Handheld portable fundus camera image; FOV: 60 degrees:
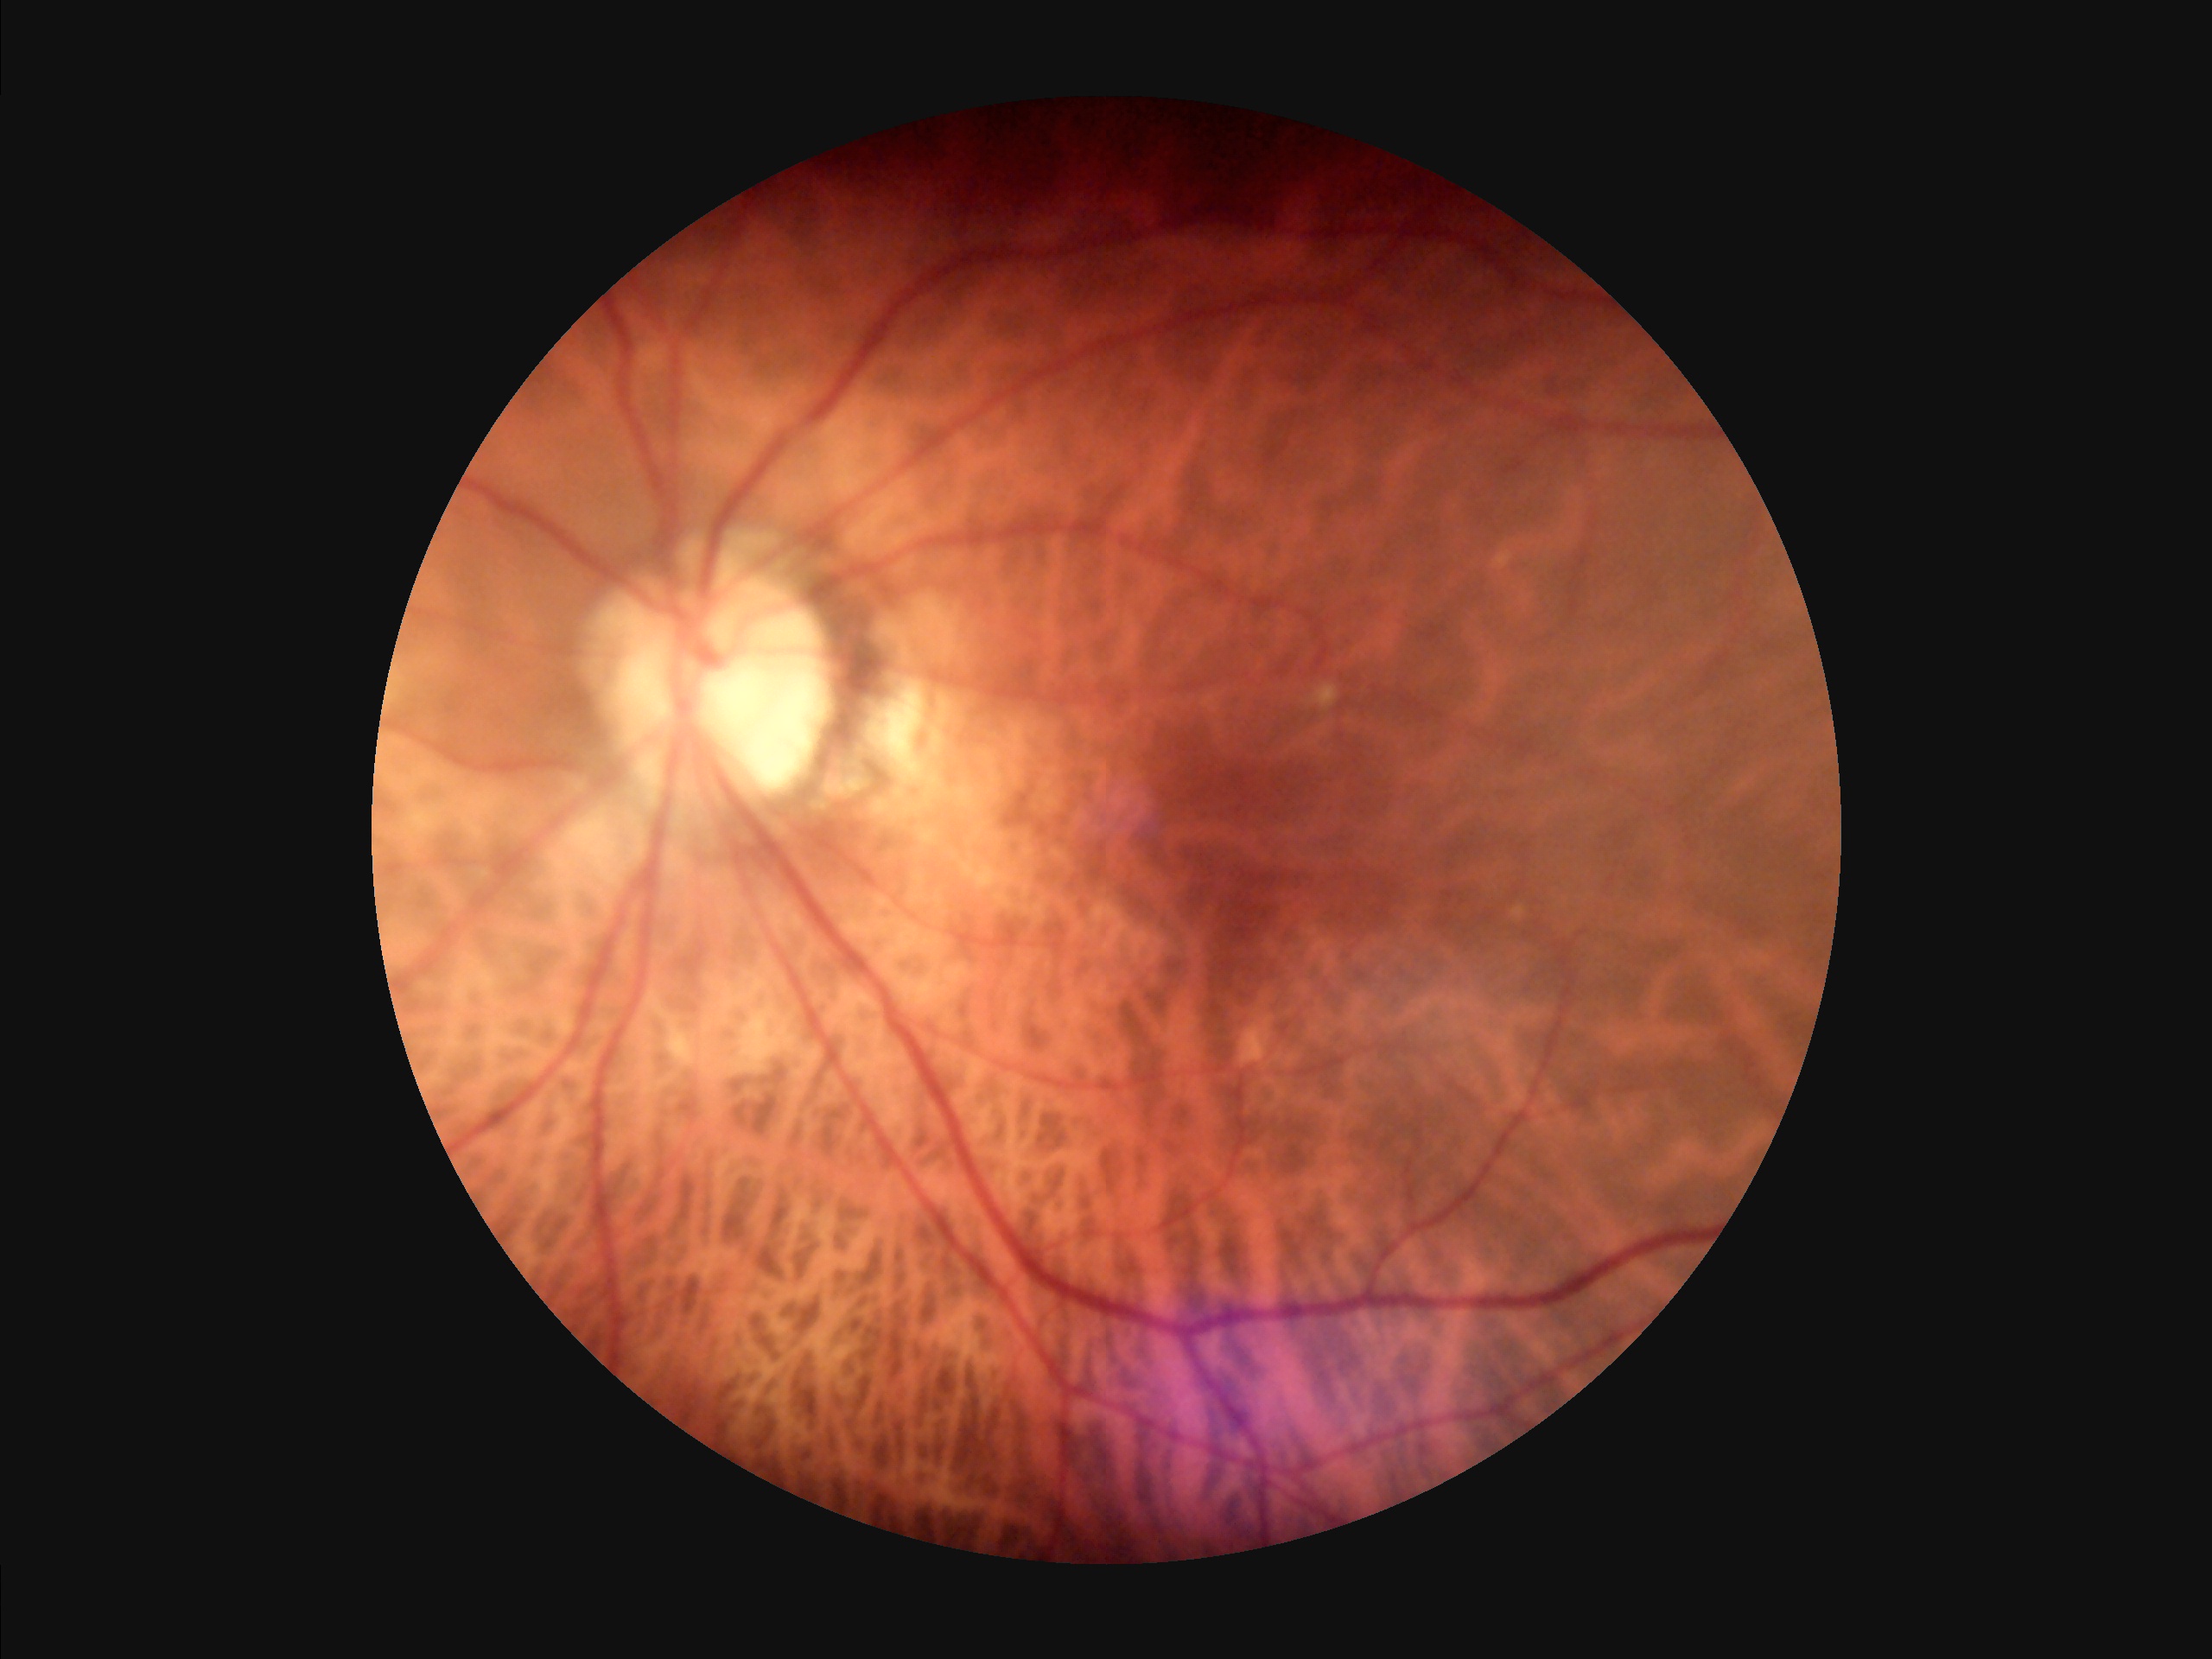 No over- or under-exposure. Optic disc, vessels, and background are in focus. Overall image quality is good.